Nonmydriatic, NIDEK AFC-230 — 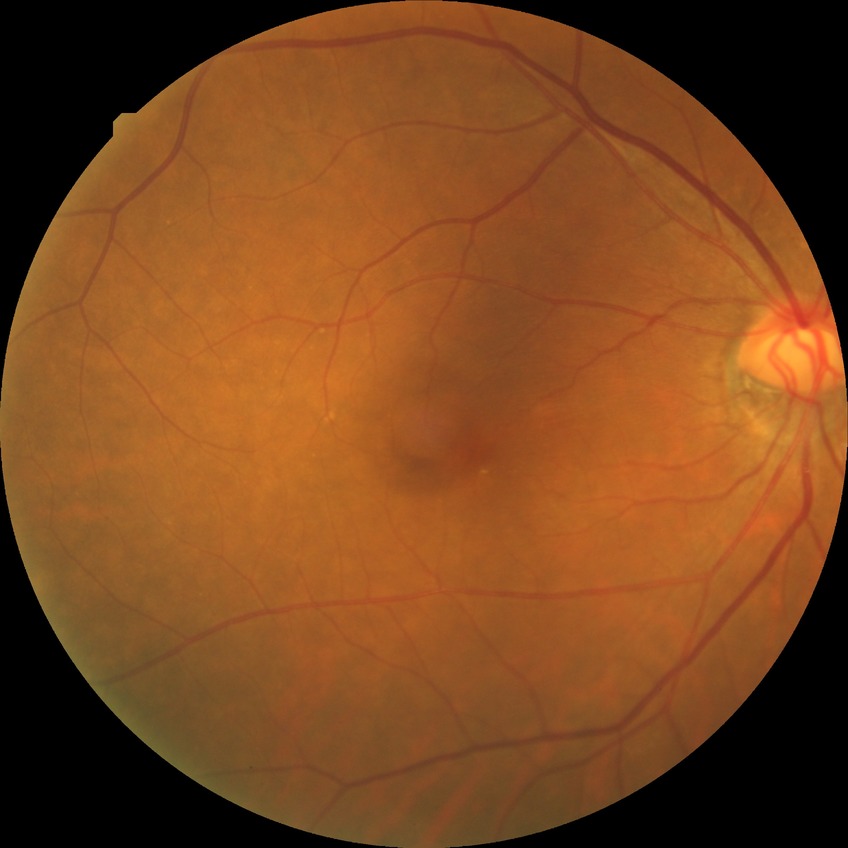 Davis grading: no diabetic retinopathy.